Image size 2352x1568 — 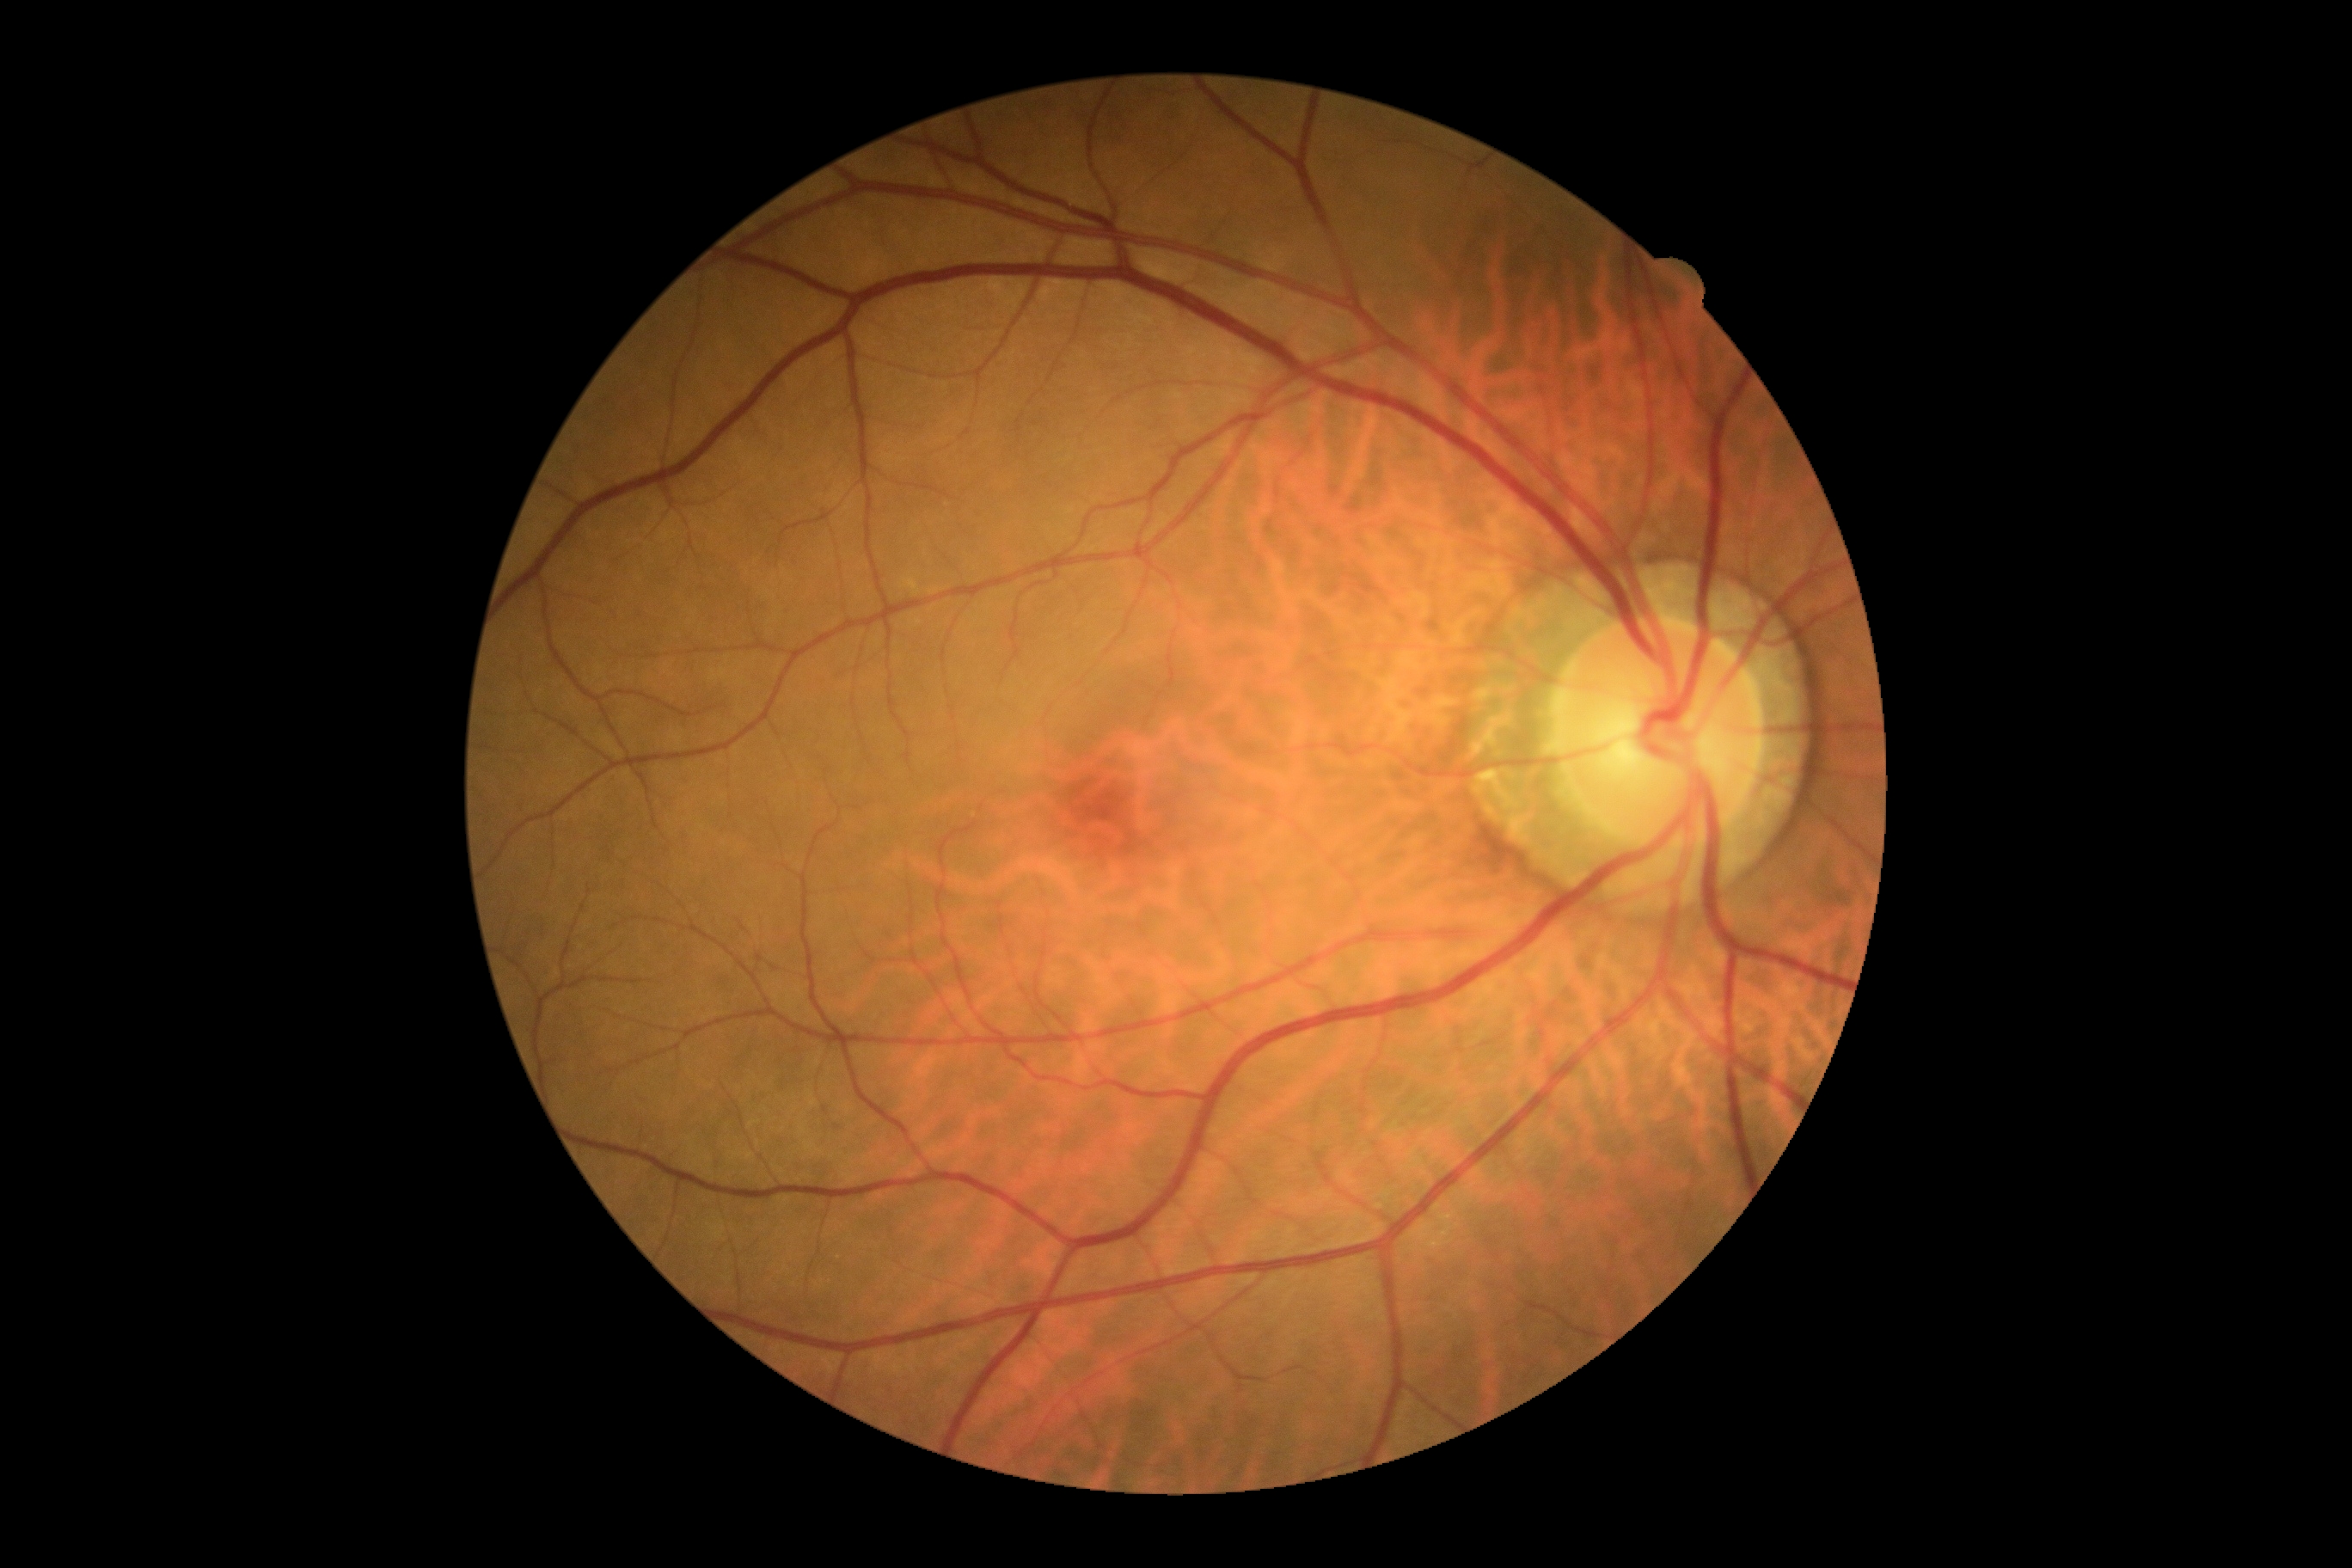 {
  "dr_grade": "0",
  "dr_impression": "no apparent DR"
}